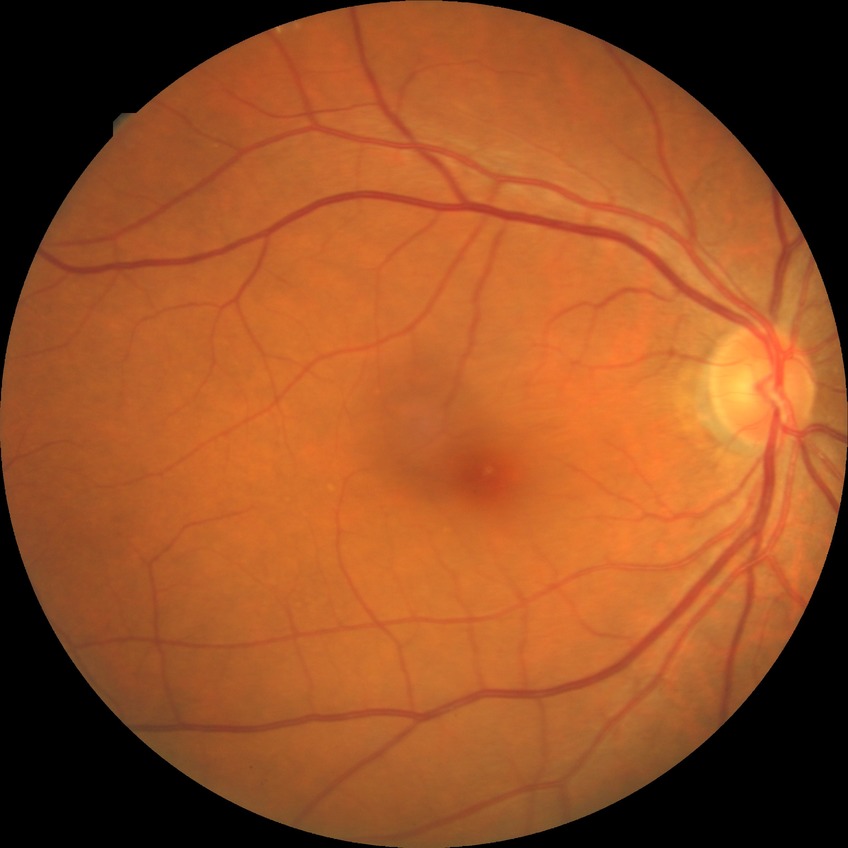 {
  "davis_grade": "NDR (no diabetic retinopathy)"
}